RetCam wide-field infant fundus image. Captured with the Clarity RetCam 3 (130° field of view). 640 by 480 pixels.
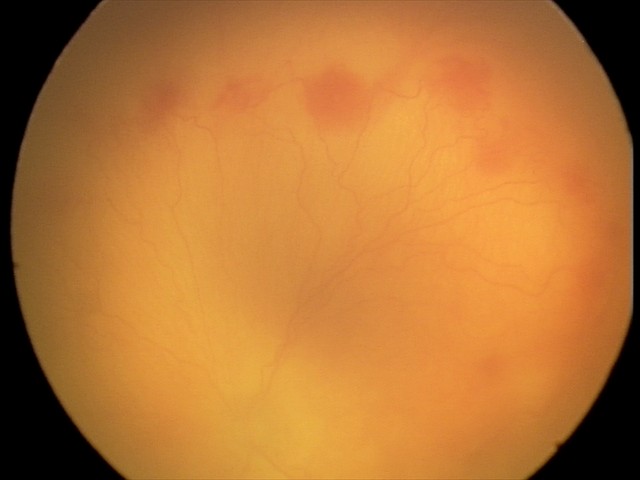 With plus disease. Series diagnosed as aggressive retinopathy of prematurity (A-ROP).